45° field of view — 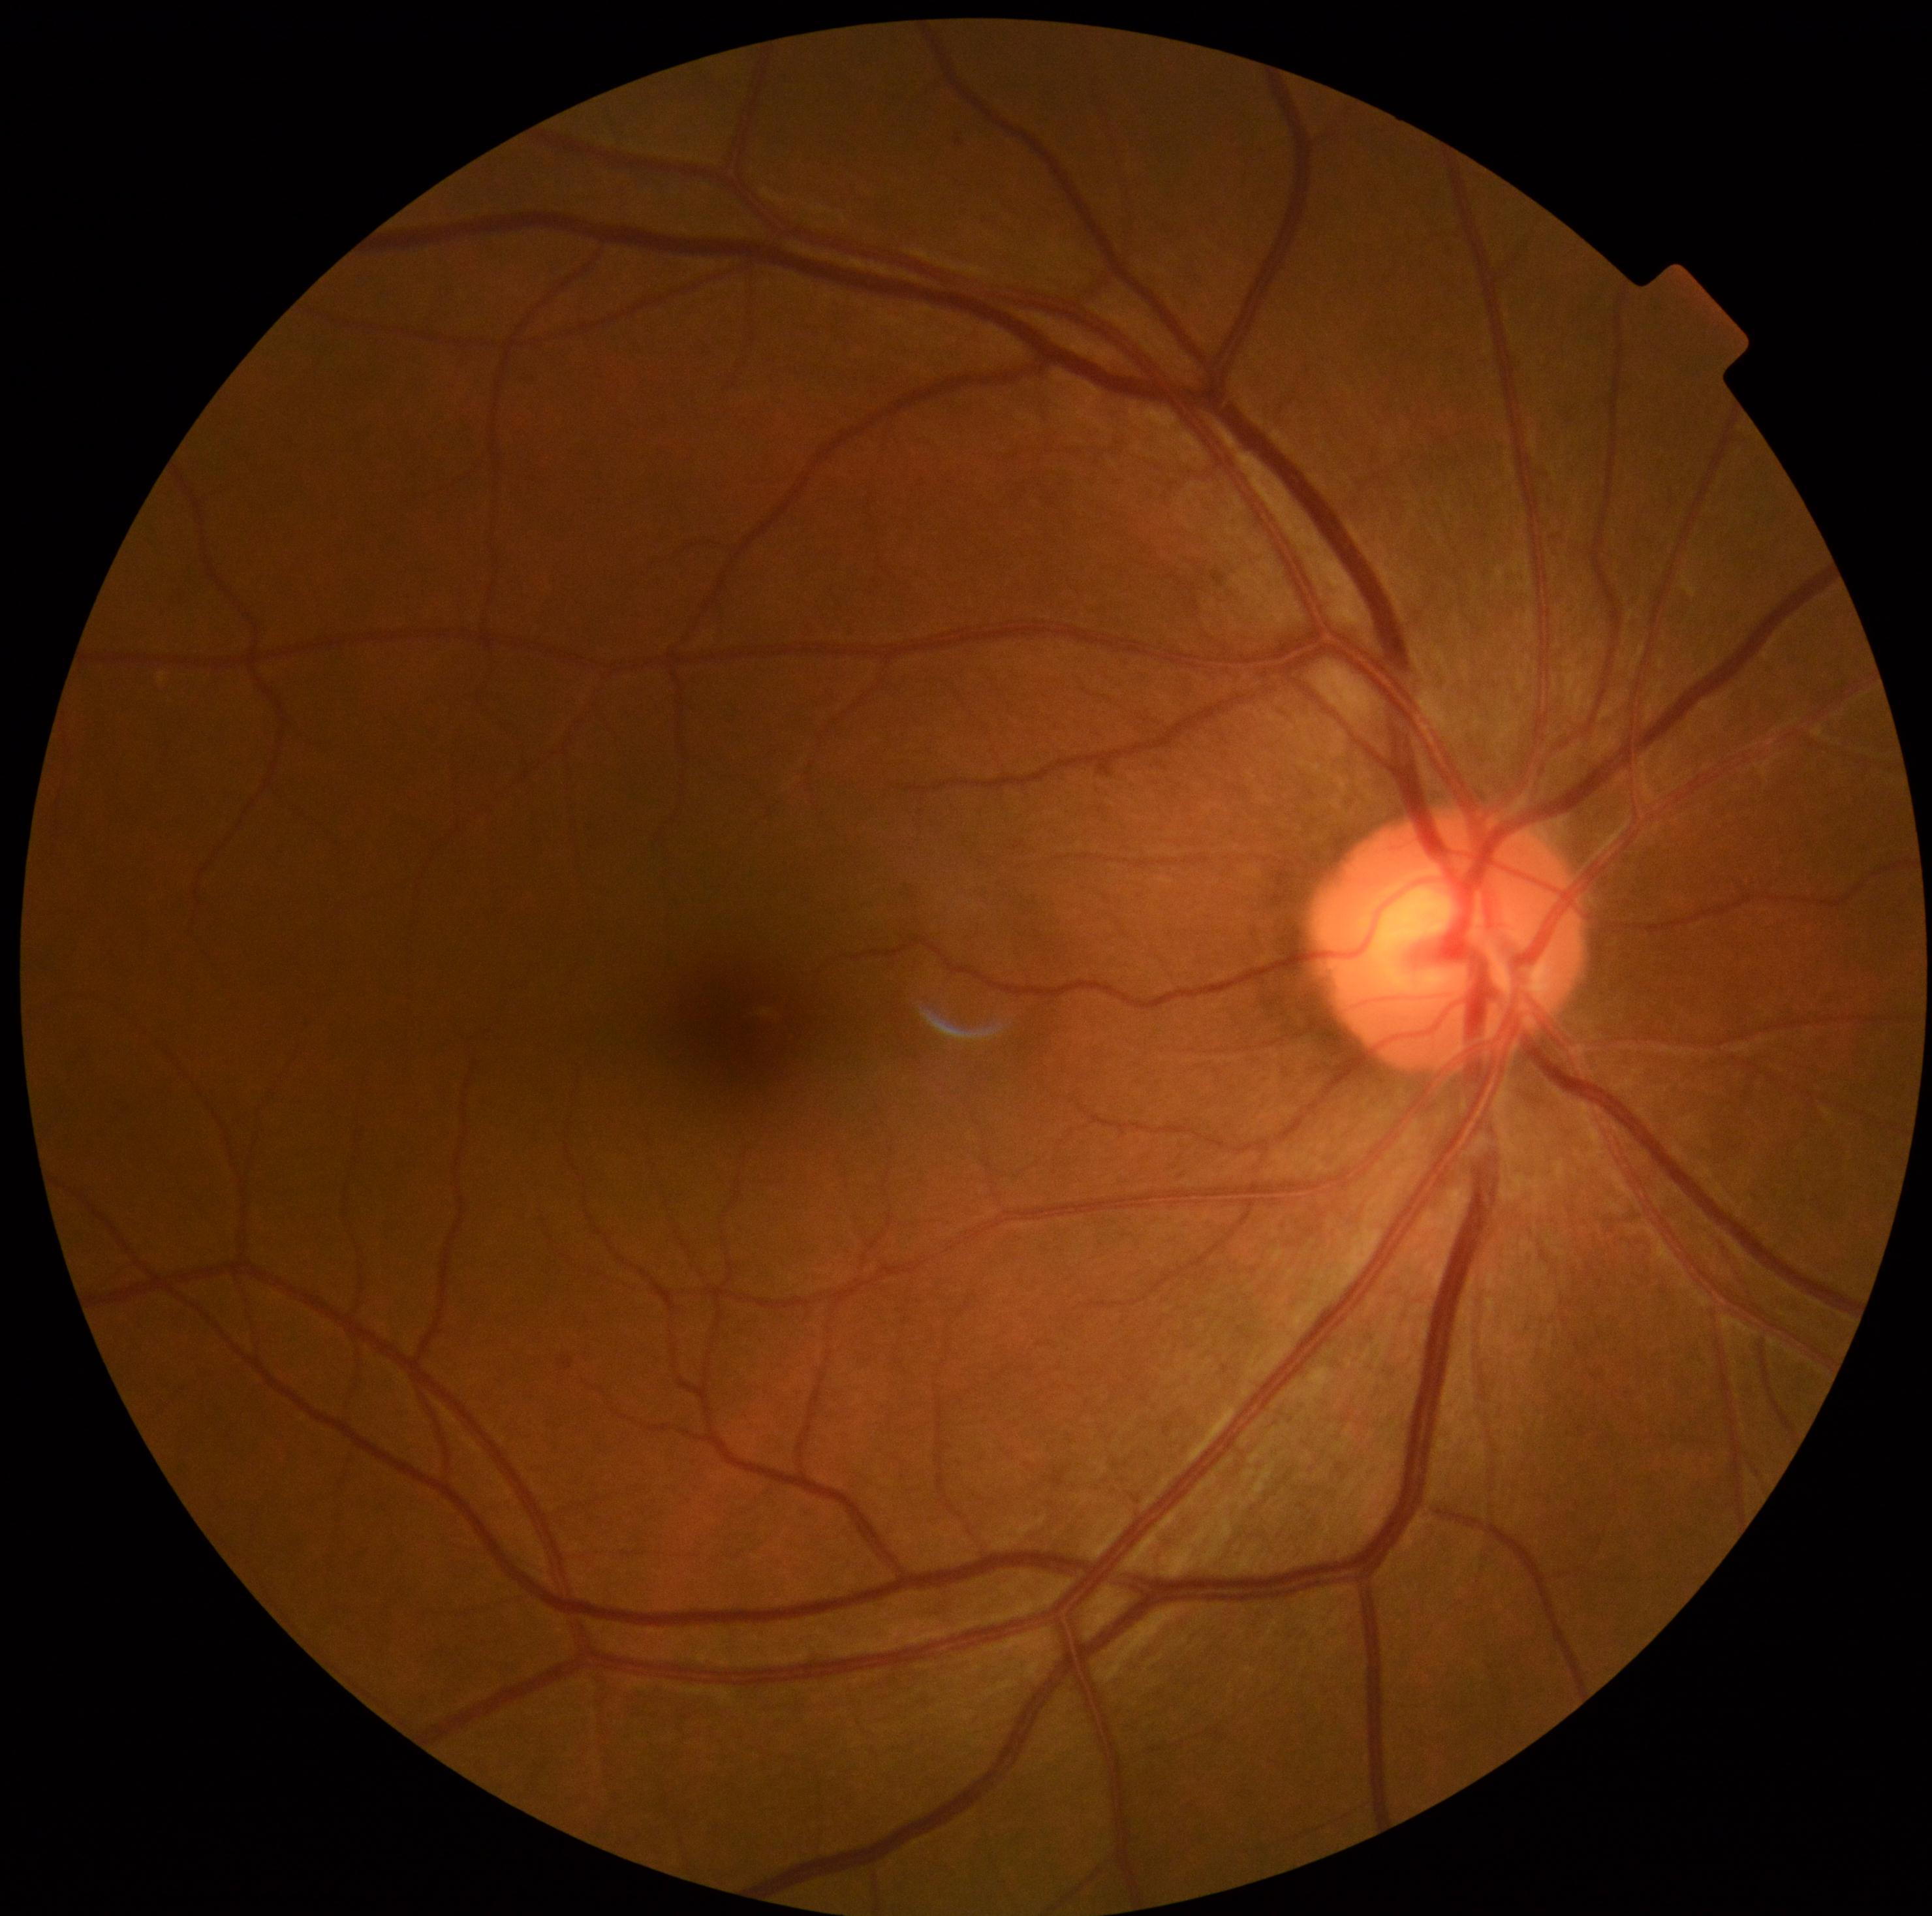 Diabetic retinopathy is grade 0 (no apparent retinopathy) — no visible signs of diabetic retinopathy. No apparent diabetic retinopathy.